45-degree field of view; camera: NIDEK AFC-230:
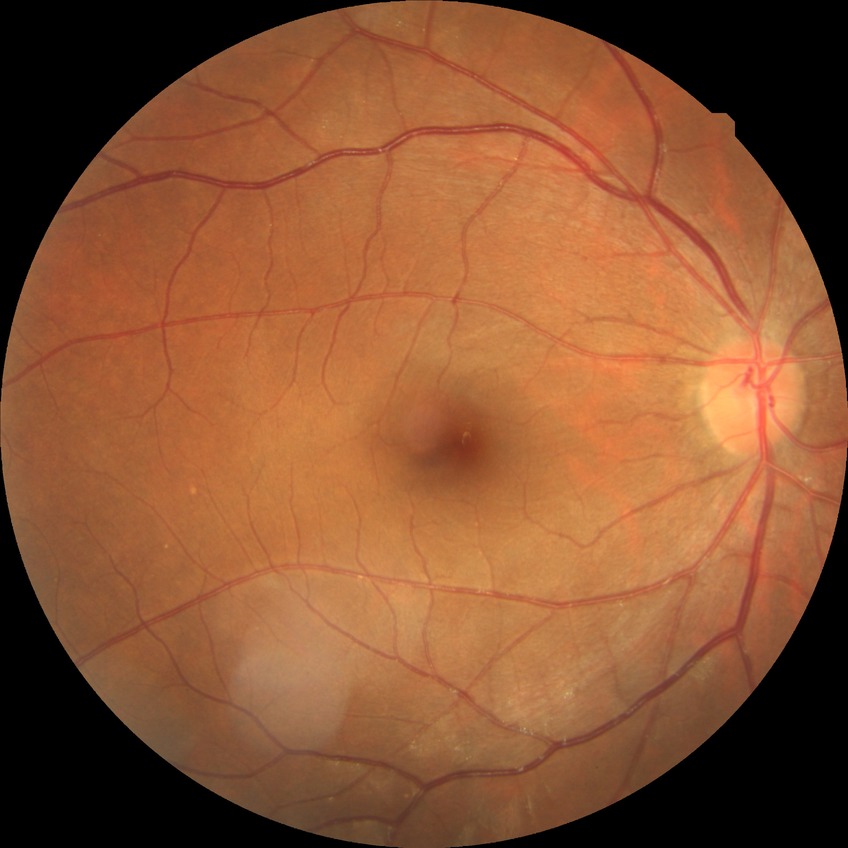
Diabetic retinopathy (DR) is NDR (no diabetic retinopathy).